FOV: 45 degrees, fundus photo, 2048 x 1536 pixels:
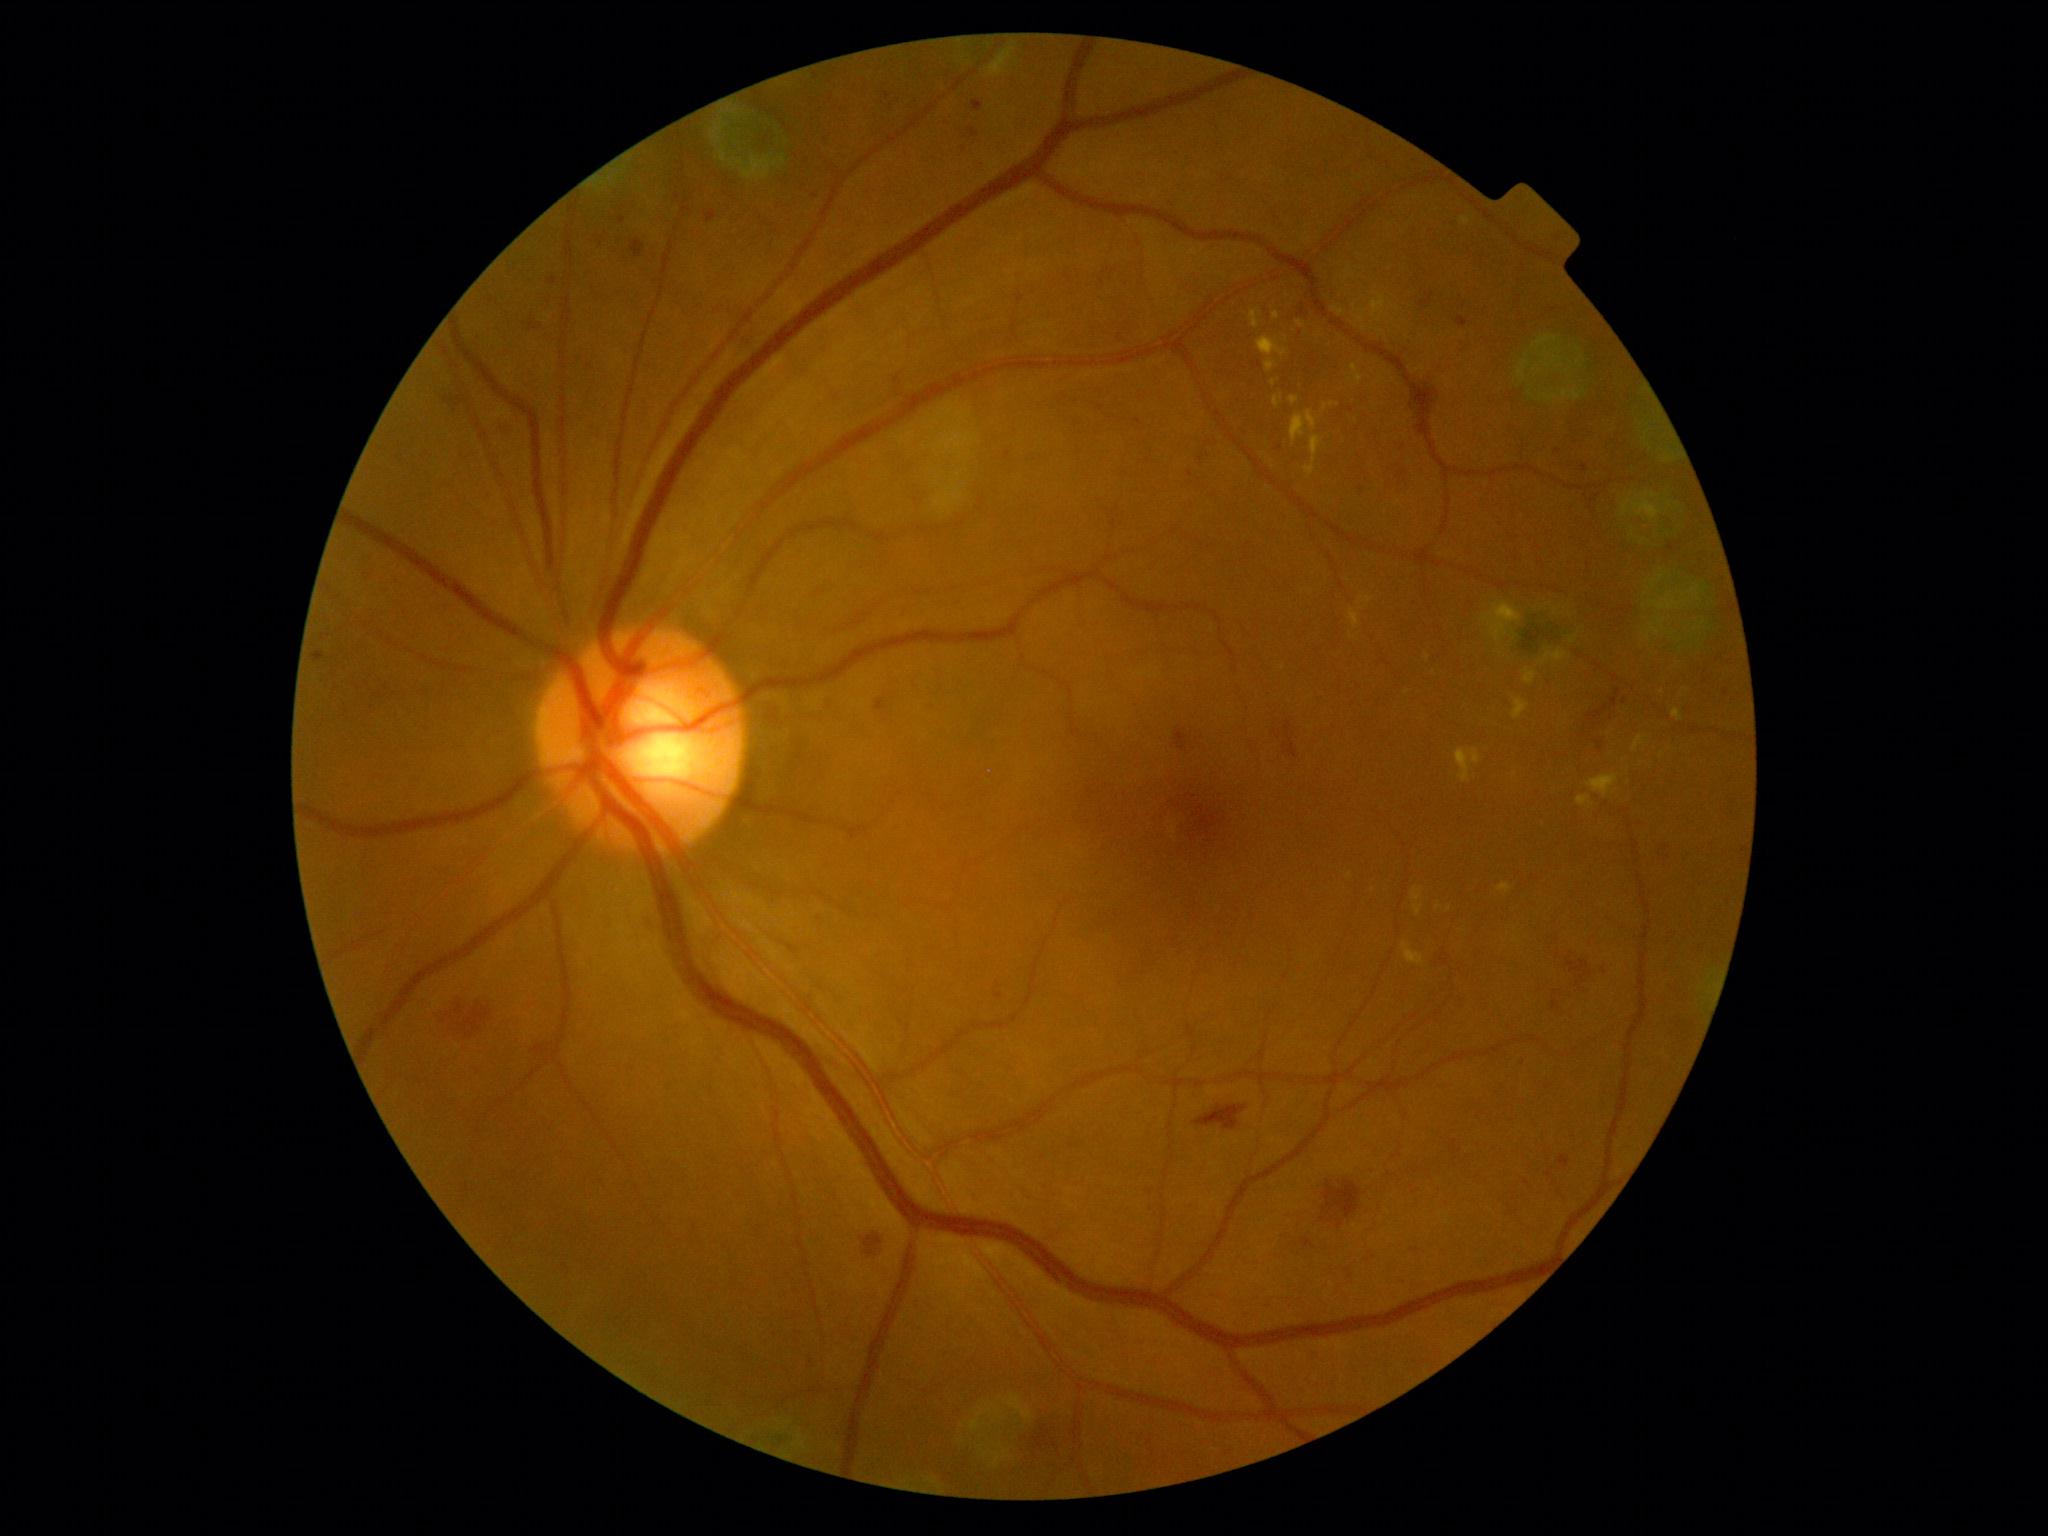

Diabetic retinopathy (DR) is grade 2
A subset of detected lesions:
soft exudates (SEs): l=916, t=394, r=984, b=516
hemorrhages (HEs) (more not shown): l=439, t=998, r=490, b=1039; l=1419, t=293, r=1434, b=310; l=1662, t=843, r=1671, b=861; l=861, t=1237, r=882, b=1258; l=1427, t=379, r=1442, b=415; l=1596, t=742, r=1602, b=752; l=1175, t=729, r=1189, b=753; l=1299, t=304, r=1305, b=317; l=1199, t=455, r=1205, b=463; l=502, t=418, r=513, b=436; l=1196, t=1105, r=1248, b=1130
Small HEs near <point>1624, 703</point>
hard exudates (EXs) (more not shown): l=1249, t=310, r=1262, b=330; l=1672, t=709, r=1684, b=722; l=1256, t=337, r=1288, b=373; l=1632, t=736, r=1645, b=753; l=1274, t=396, r=1282, b=407; l=1456, t=749, r=1482, b=783; l=1542, t=649, r=1568, b=666; l=1304, t=436, r=1322, b=478; l=1324, t=403, r=1335, b=412; l=1523, t=669, r=1536, b=684; l=1496, t=601, r=1515, b=618; l=1414, t=904, r=1424, b=917; l=1297, t=321, r=1304, b=329
Small EXs near <point>1439, 908</point>; <point>1515, 929</point>; <point>1276, 316</point>
microaneurysms (MAs) (more not shown): l=995, t=994, r=1003, b=998; l=618, t=217, r=627, b=225; l=968, t=128, r=980, b=138; l=706, t=211, r=717, b=224; l=529, t=323, r=535, b=331; l=1559, t=1156, r=1571, b=1168; l=314, t=653, r=325, b=661; l=1457, t=317, r=1469, b=329; l=876, t=699, r=888, b=712; l=972, t=100, r=984, b=113; l=548, t=278, r=558, b=286
Small MAs near <point>1585, 468</point>; <point>1604, 972</point>; <point>1139, 422</point>; <point>1523, 1061</point>; <point>887, 96</point>; <point>1727, 693</point>; <point>1210, 443</point>; <point>1190, 475</point>; <point>1558, 451</point>